Refractive error: sphere +1.25 D, cylinder -0.75 D, axis 79° · color fundus image · 56 years old.
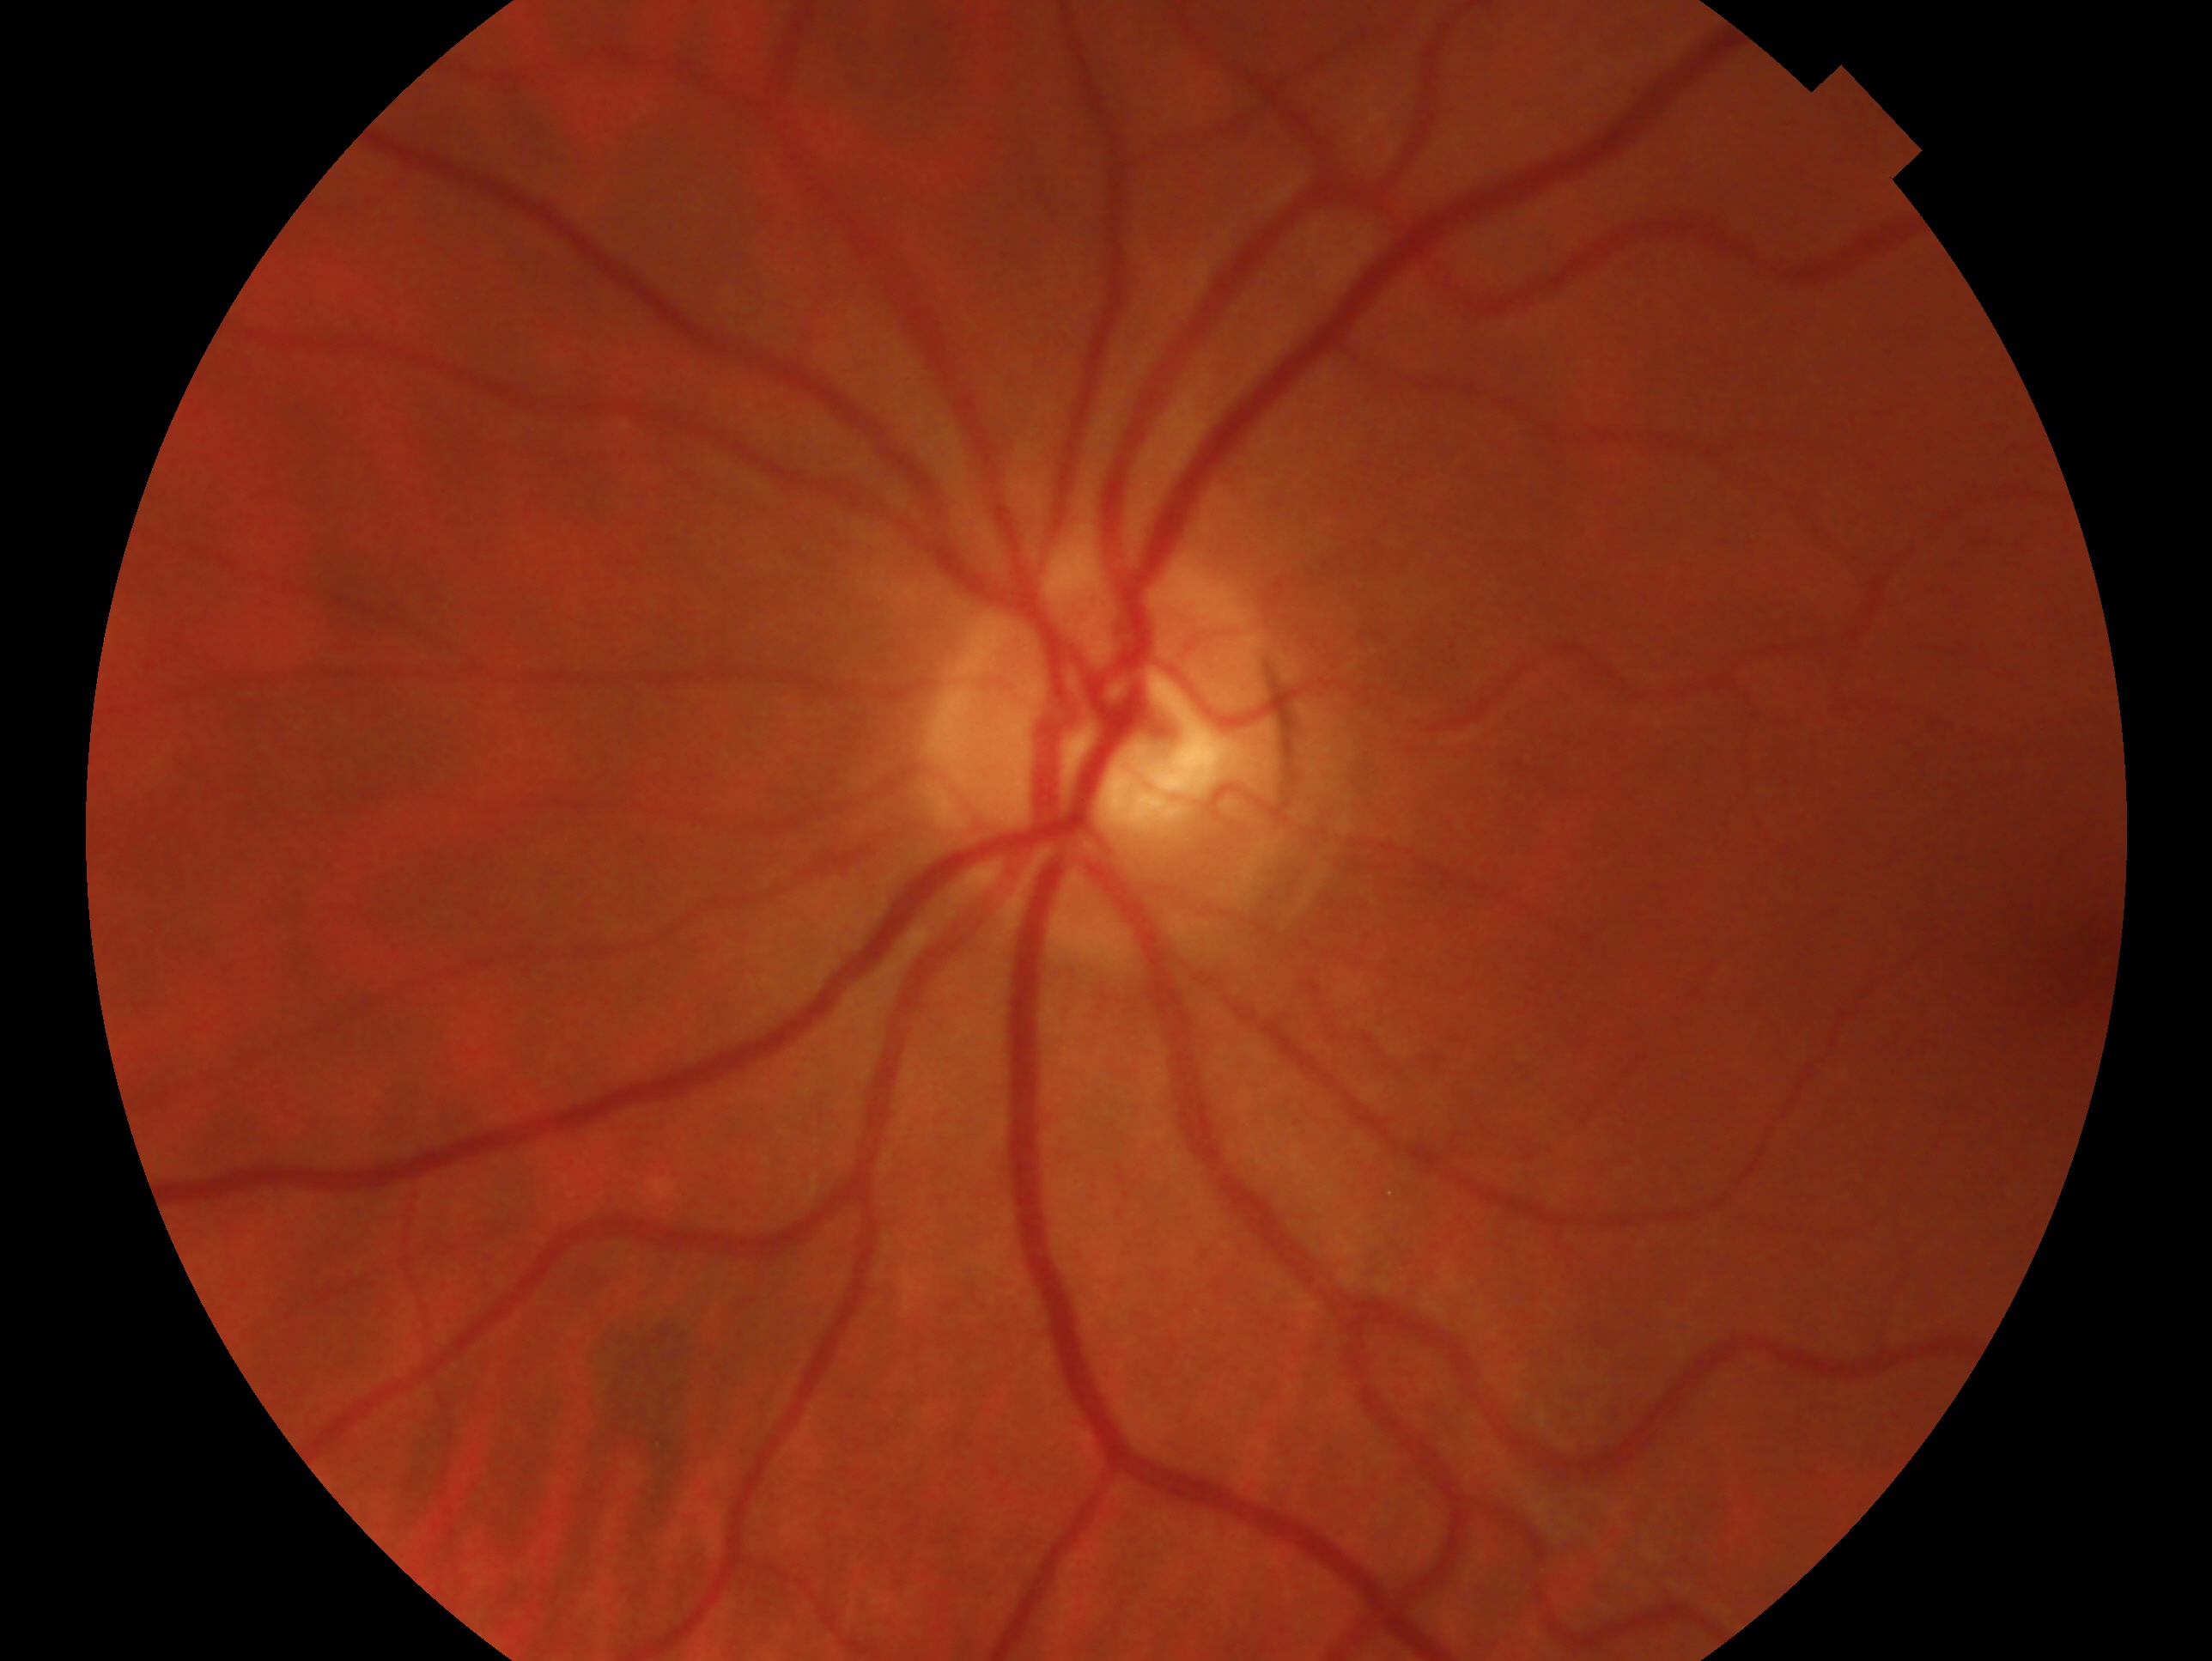
Annotations:
* assessment · no evidence of glaucoma
* laterality · left eye